Color fundus image. 848 by 848 pixels:
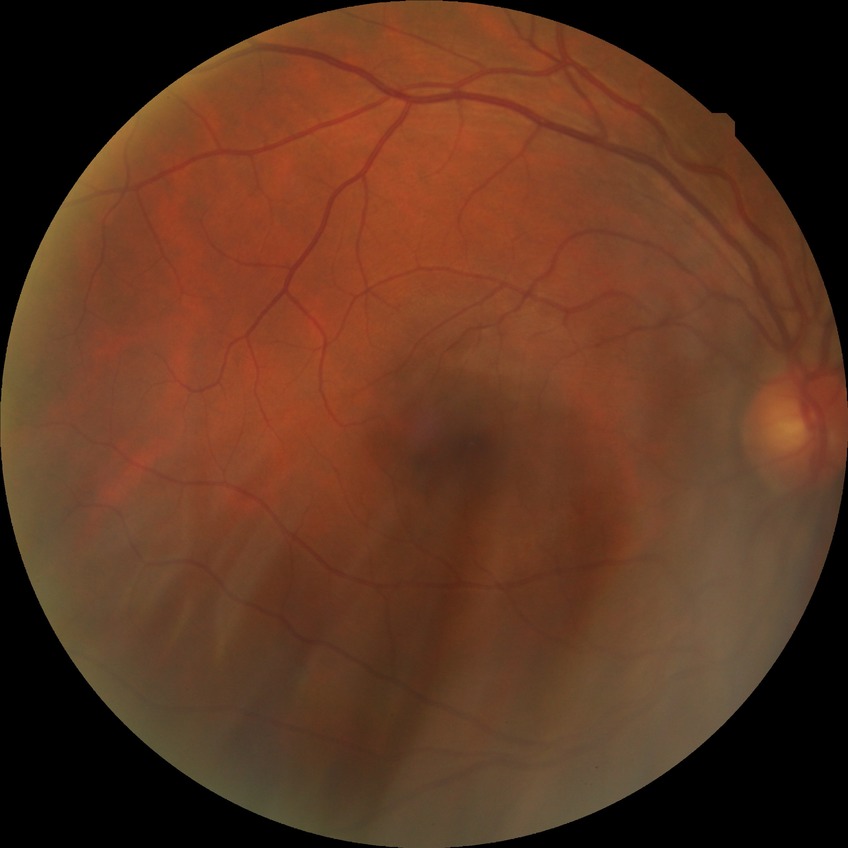
davis_grade: no diabetic retinopathy